1932 x 1932 pixels · color fundus photograph: 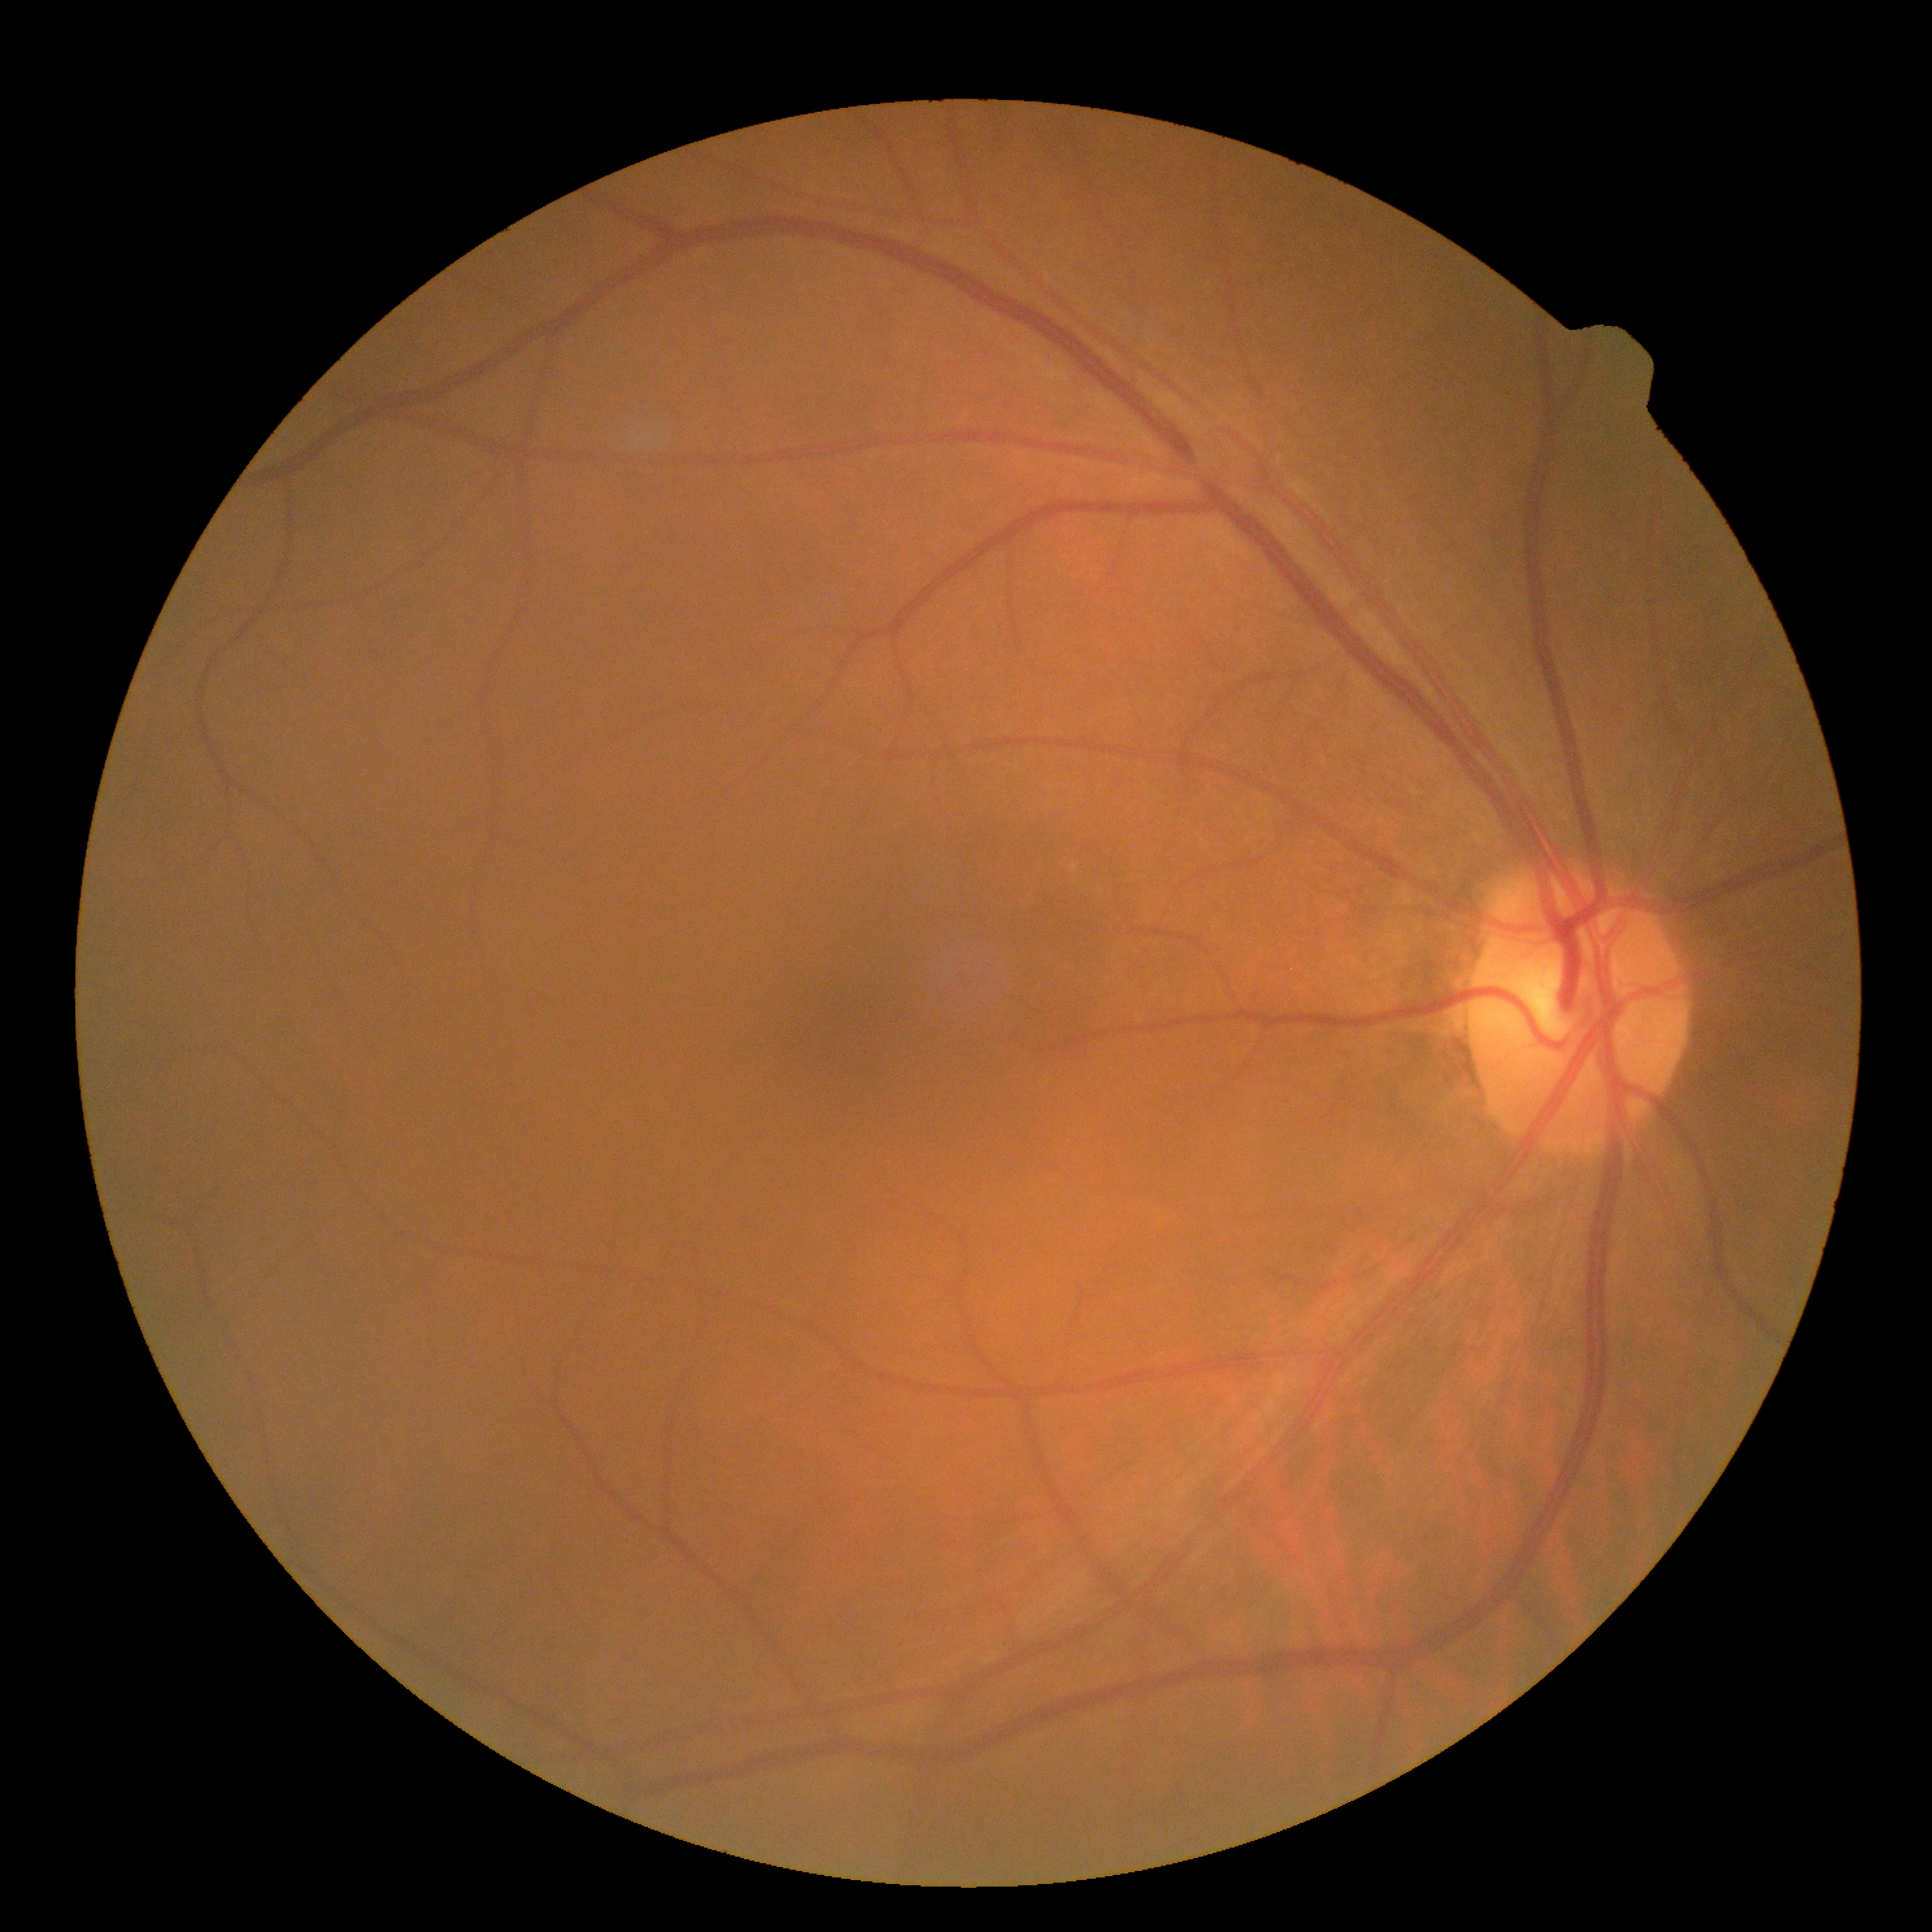 {"dr_grade": "0 (no apparent retinopathy)", "dr_impression": "no DR findings"}